FOV: 45 degrees — 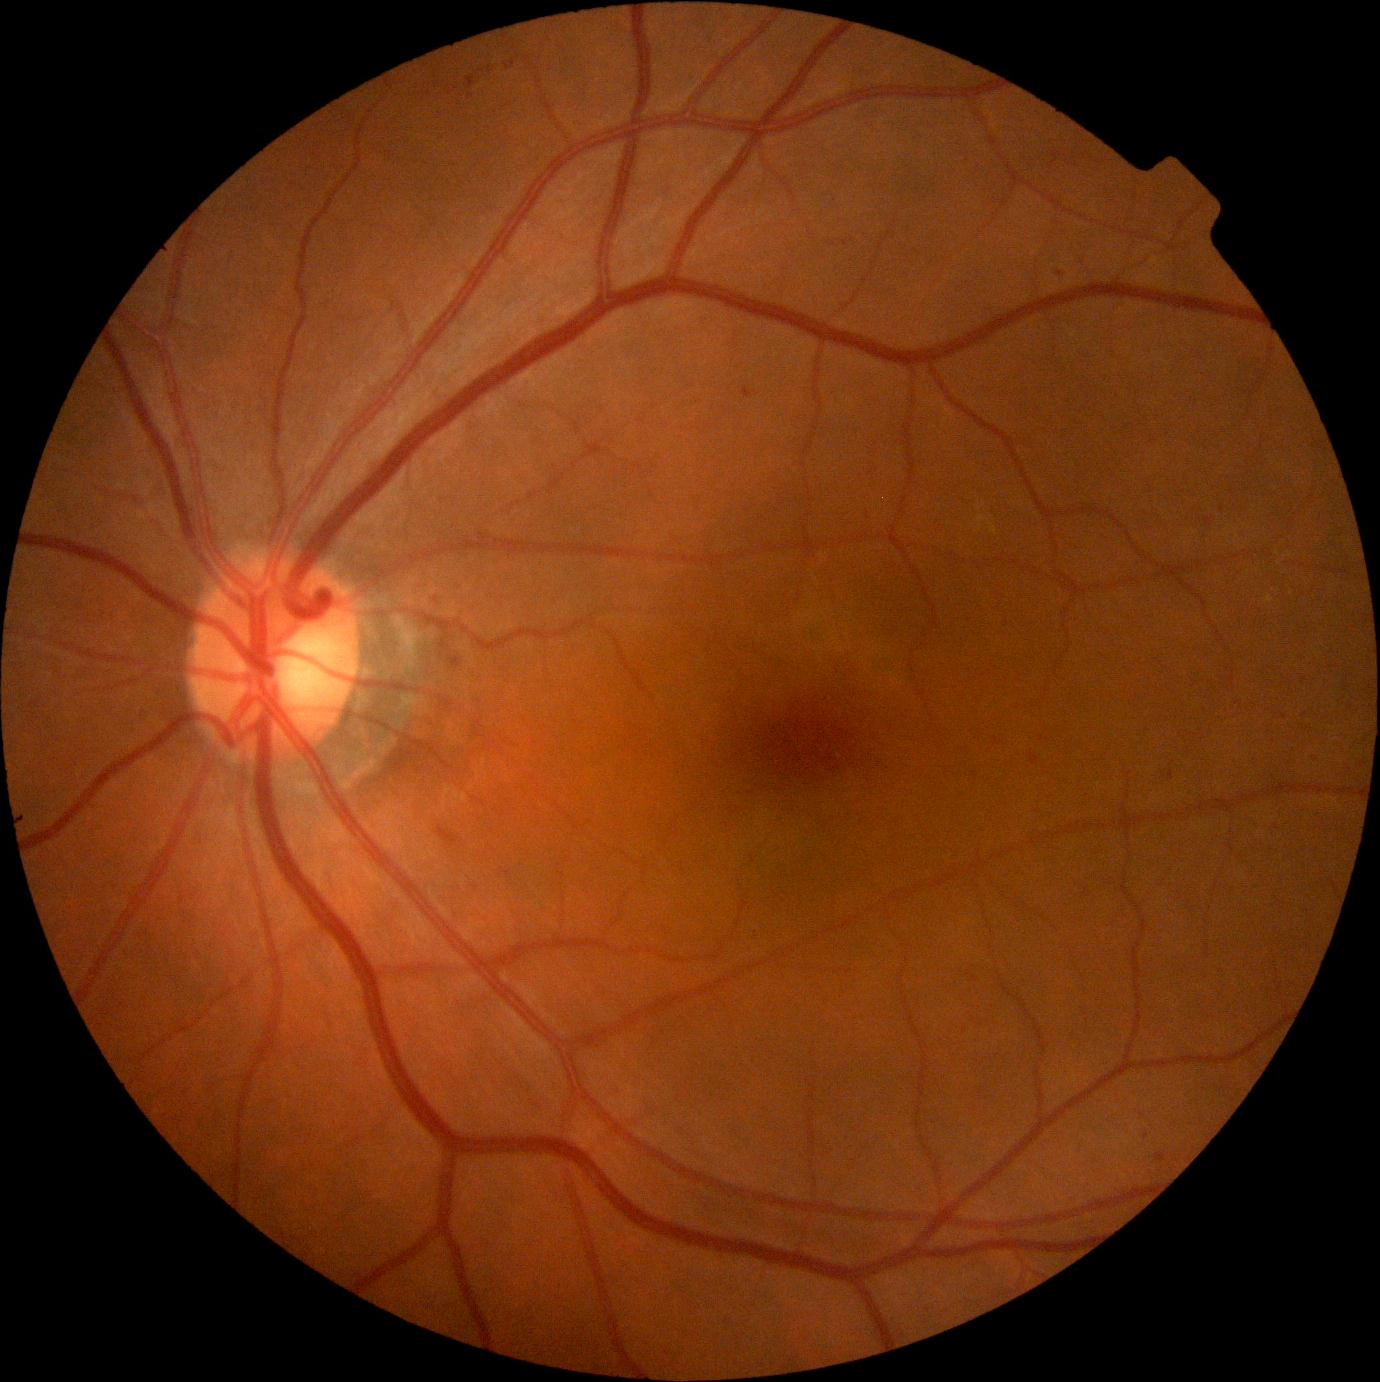

DR stage: grade 1 (mild NPDR). The retinopathy is classified as non-proliferative diabetic retinopathy.